Modified Davis grading — 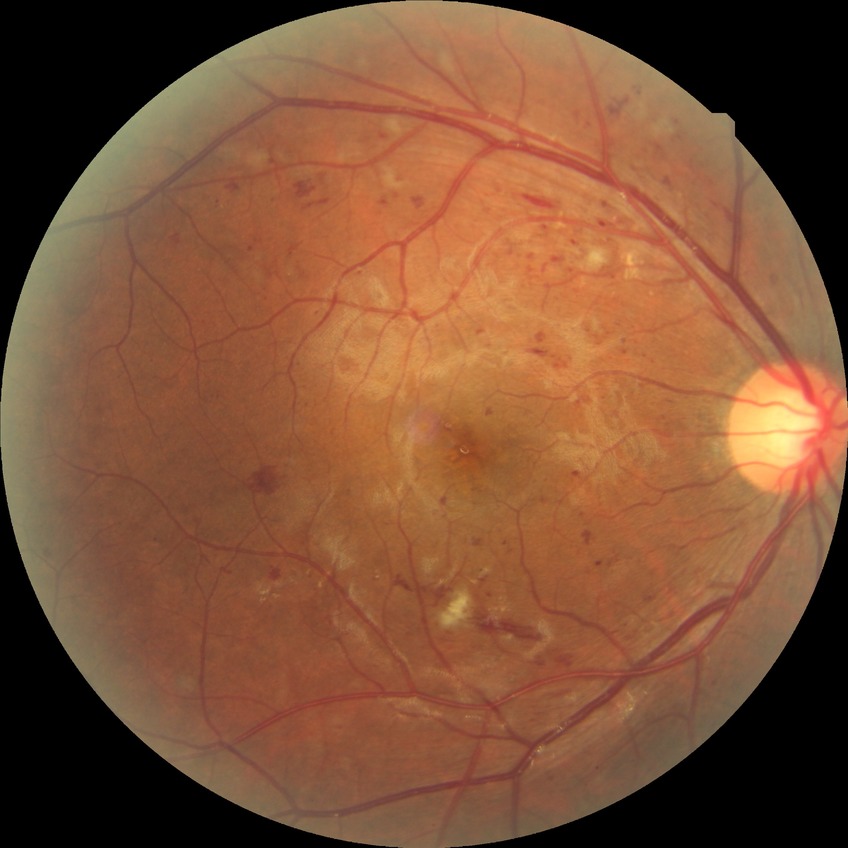 Modified Davis grade is PPDR.
The retinopathy is classified as non-proliferative diabetic retinopathy.